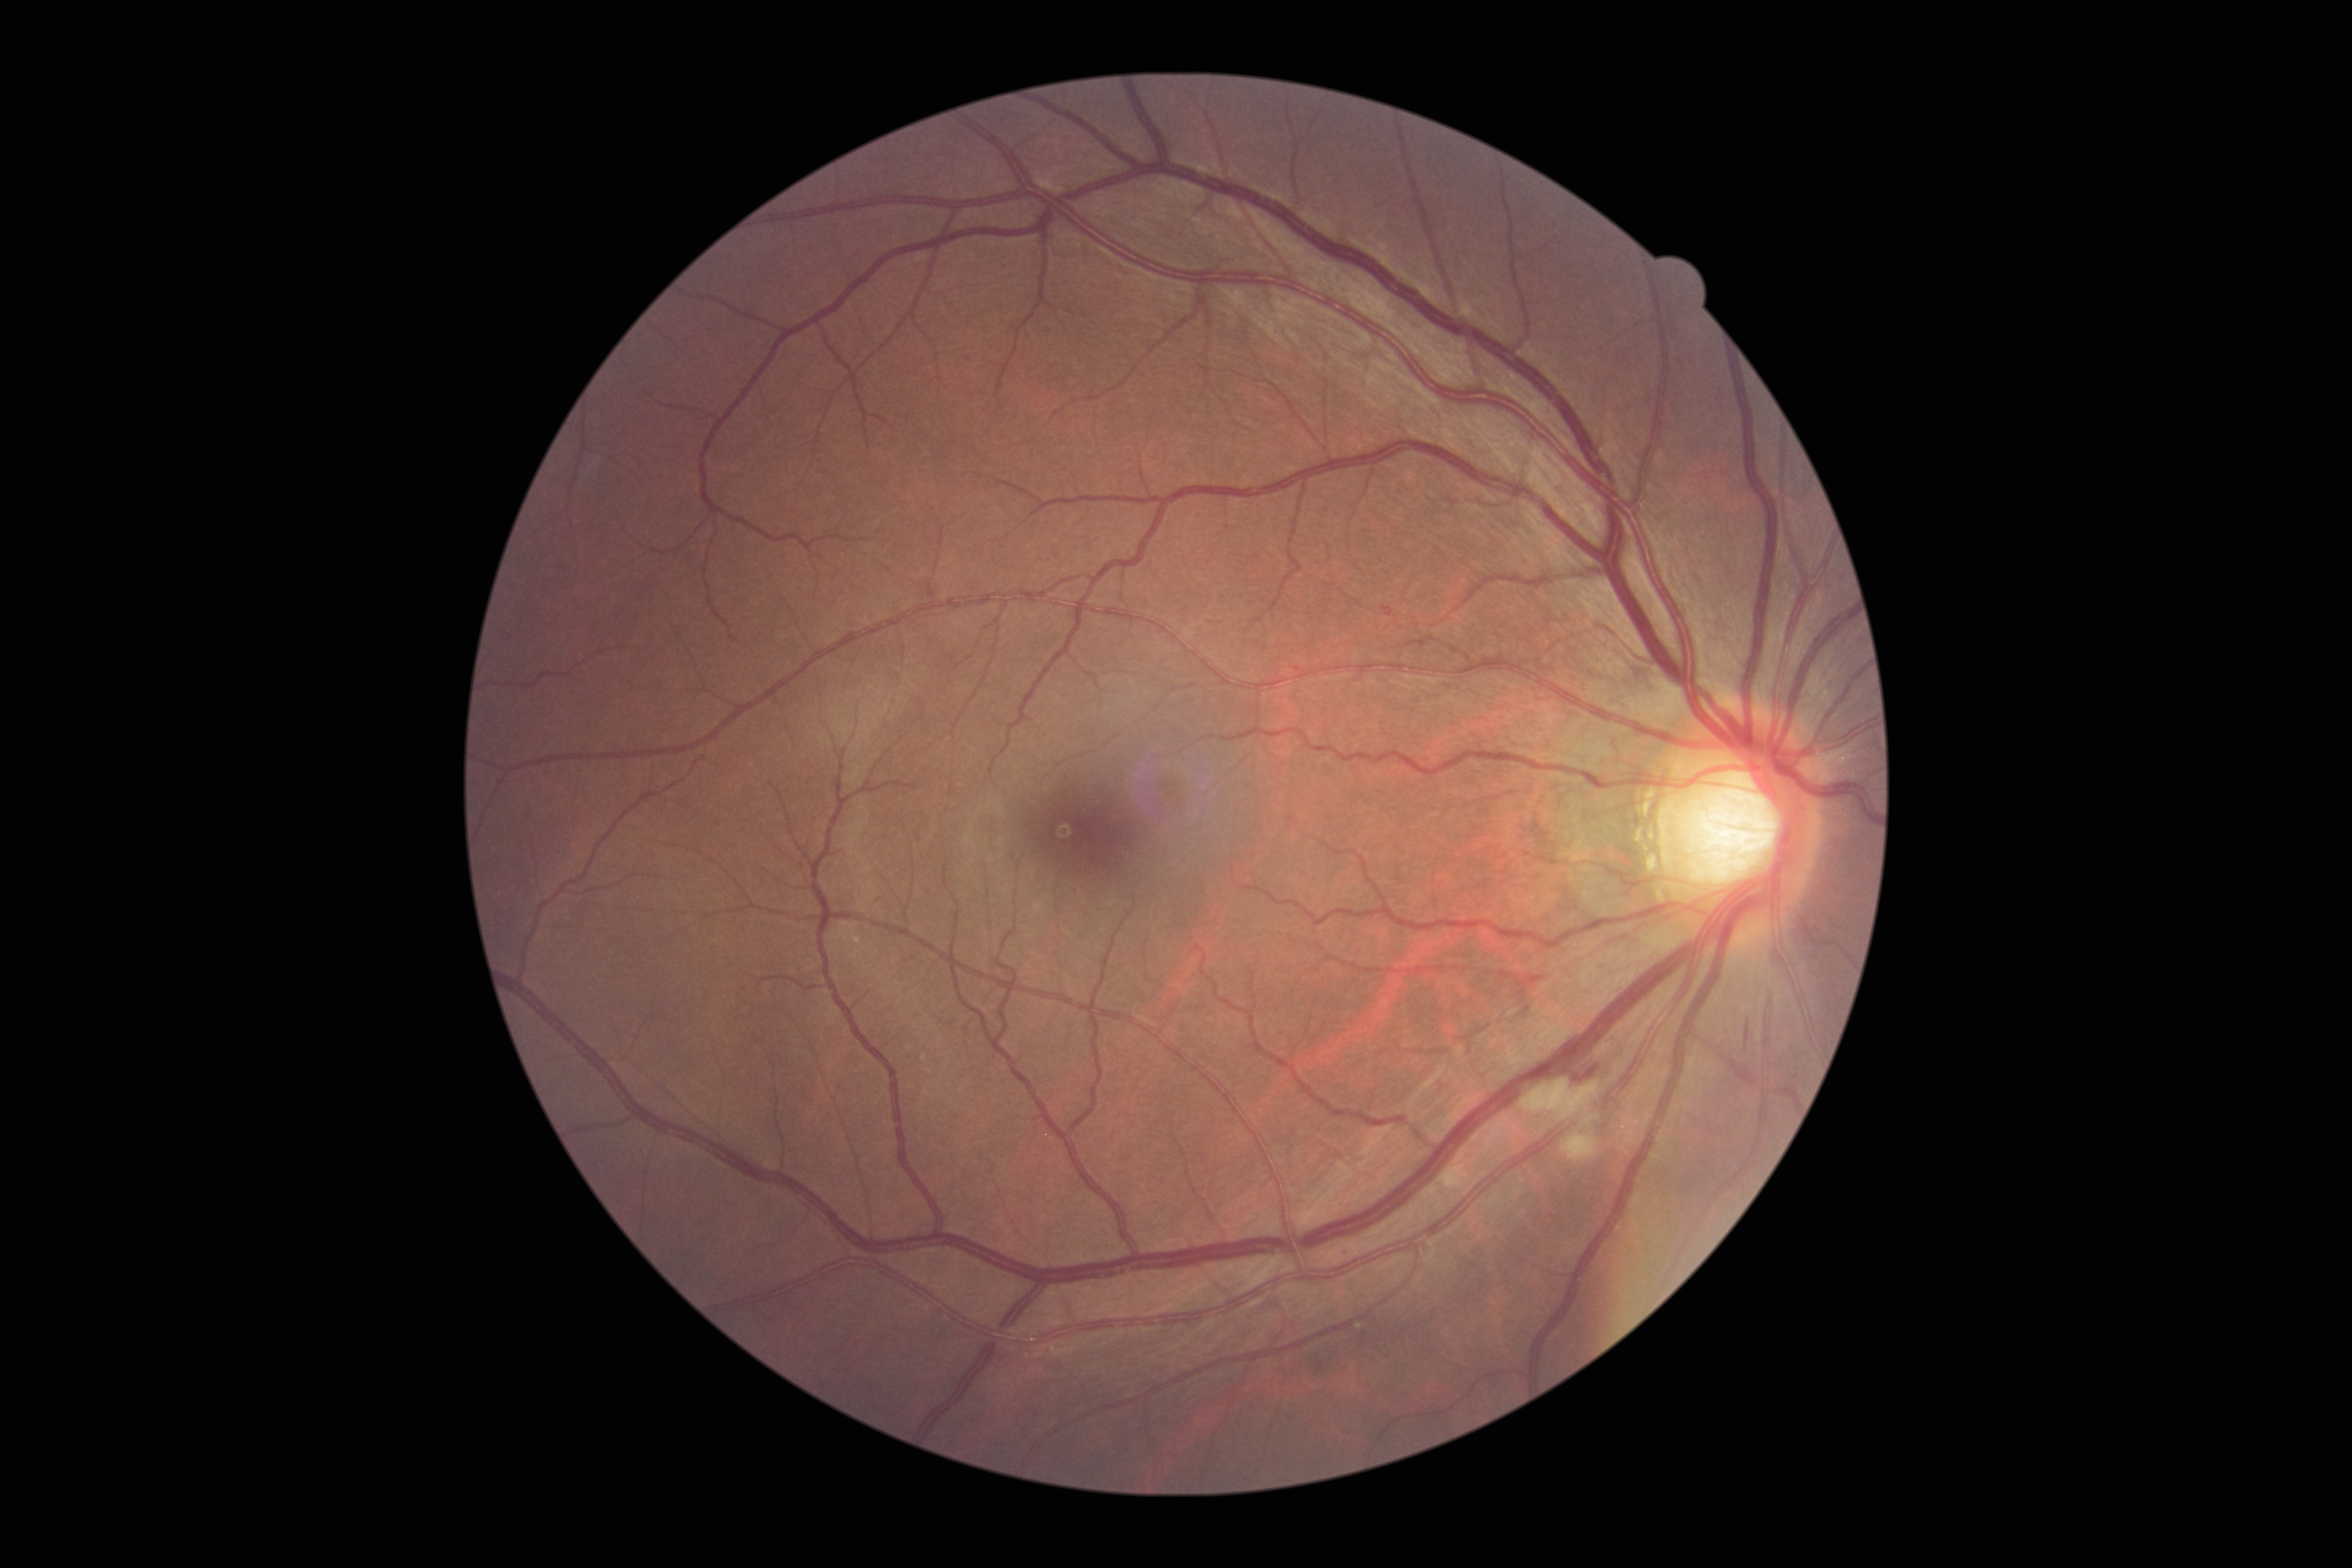 The retinopathy is classified as non-proliferative diabetic retinopathy. Diabetic retinopathy (DR): 2/4 — more than just microaneurysms but less than severe NPDR.